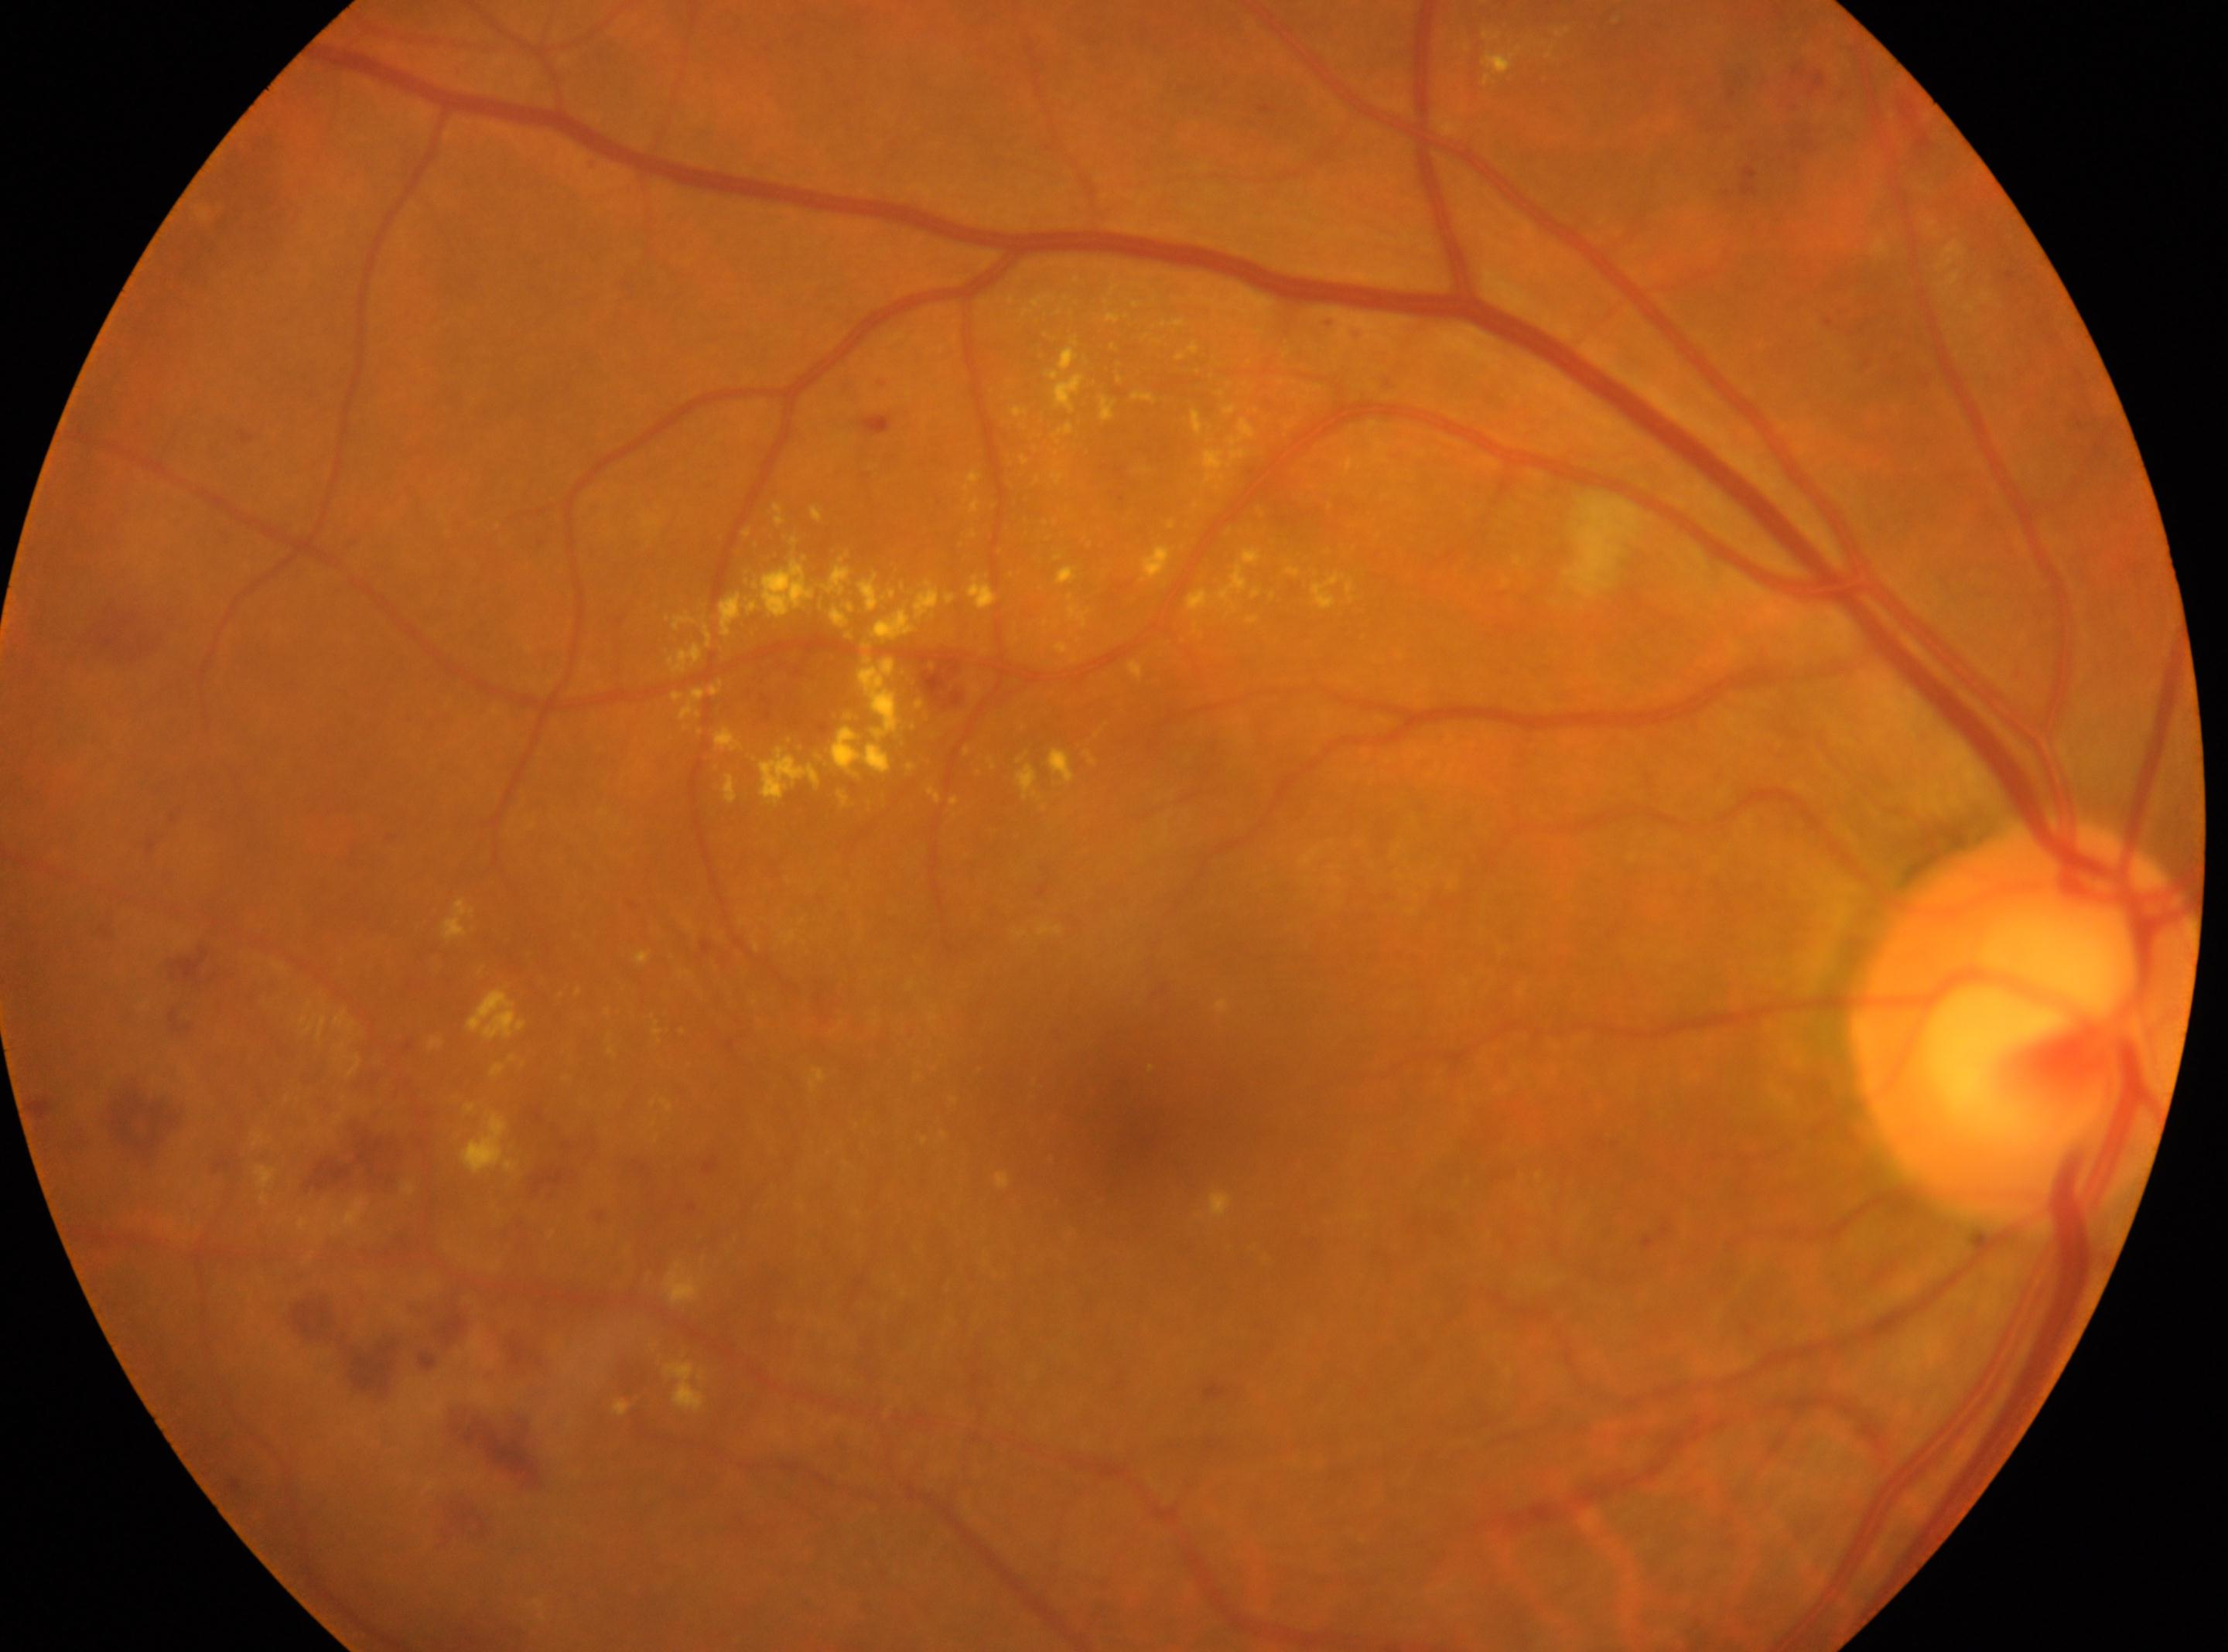

DR: grade 2 — more than just microaneurysms but less than severe NPDR. Optic nerve head: (2023, 1022). Fovea centralis: (1125, 1123). Eye: right eye.